Color fundus photograph
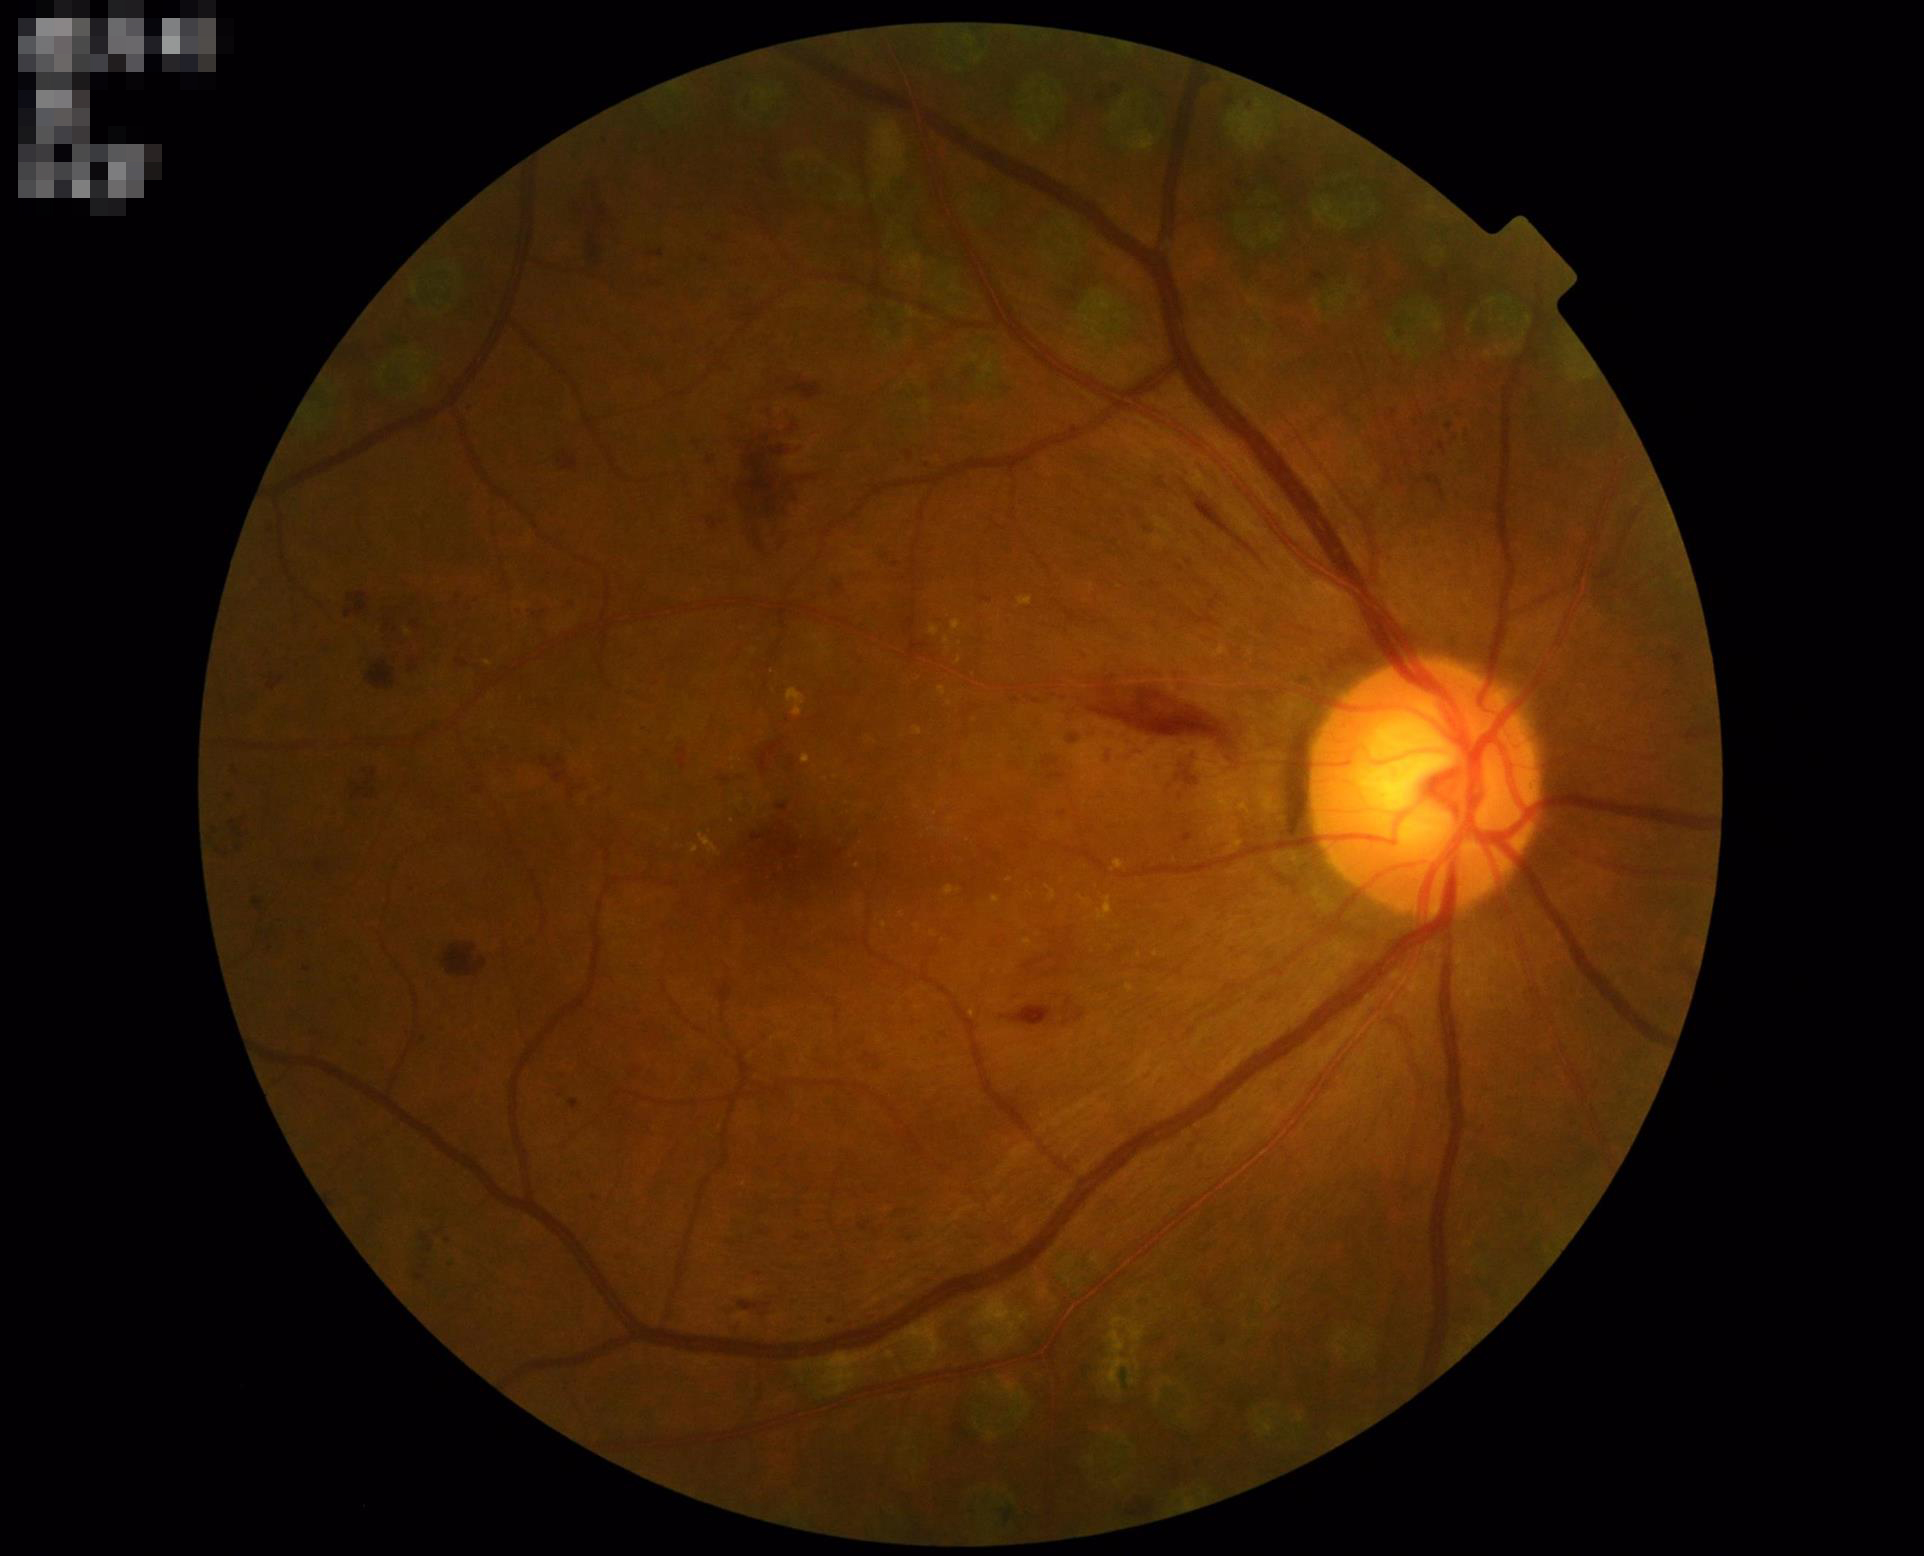
Contrast = good | Overall quality = good | Illumination/color = adequate | Focus = sharp.